No pharmacologic dilation · 848 by 848 pixels · 45° field of view — 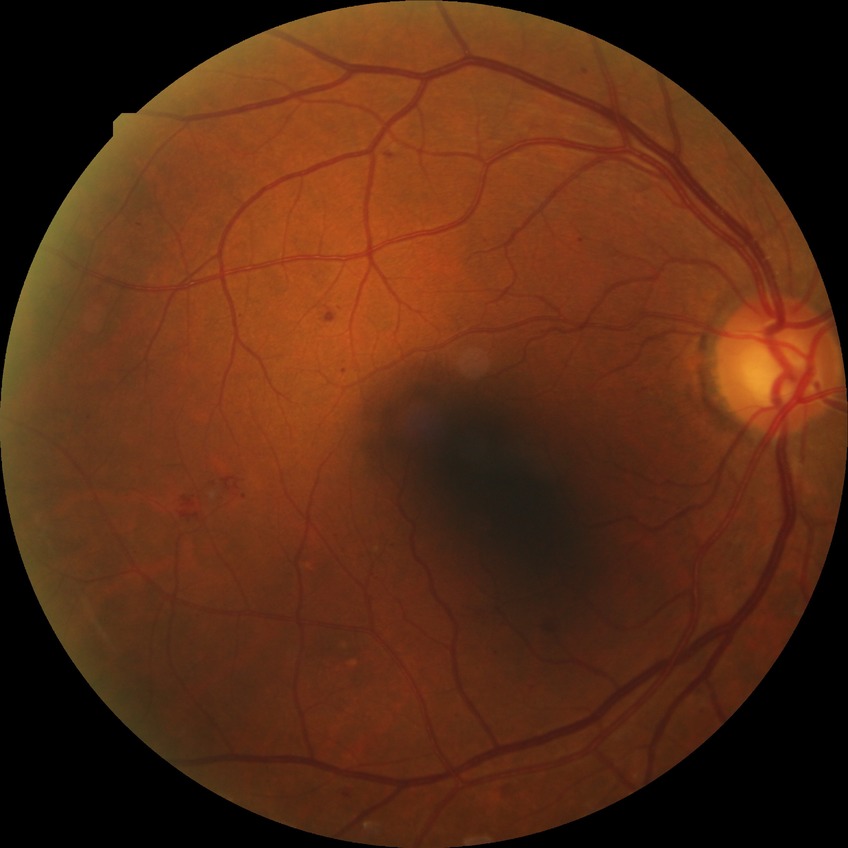

  davis_grade: SDR